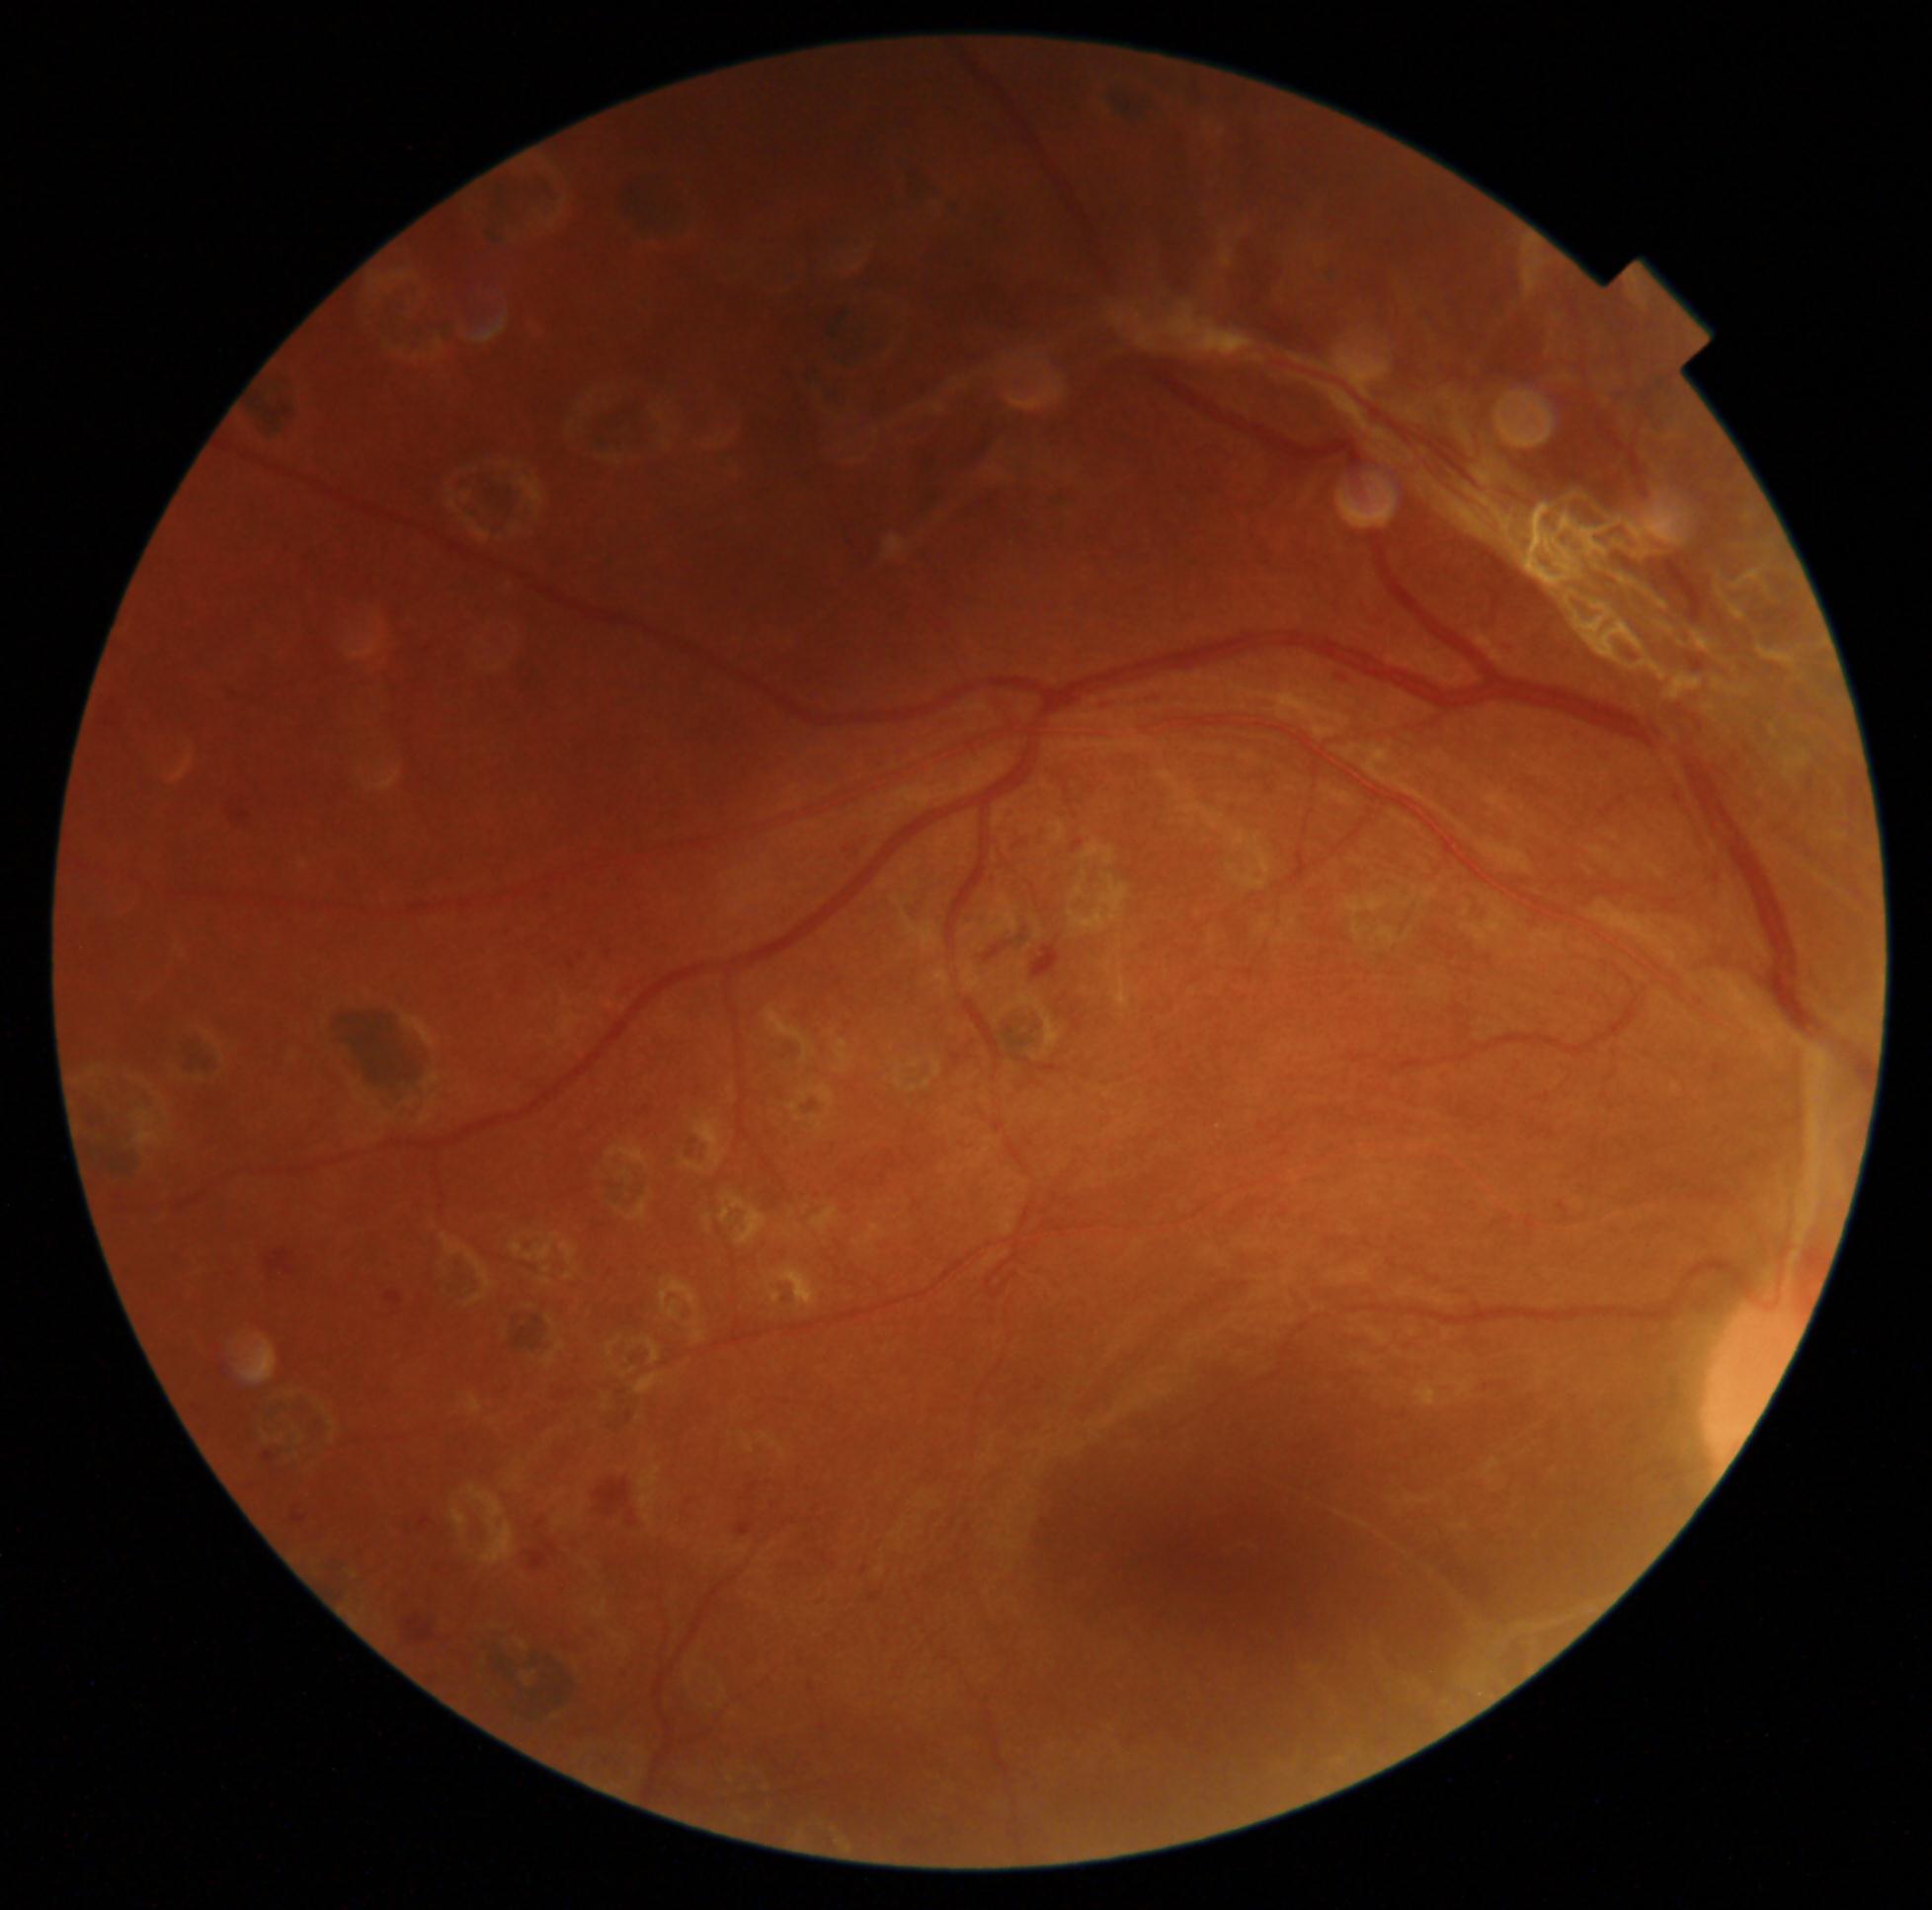

diabetic retinopathy: 4 — neovascularization and/or vitreous/pre-retinal hemorrhage, DR class: proliferative diabetic retinopathy.